Modified Davis grading.
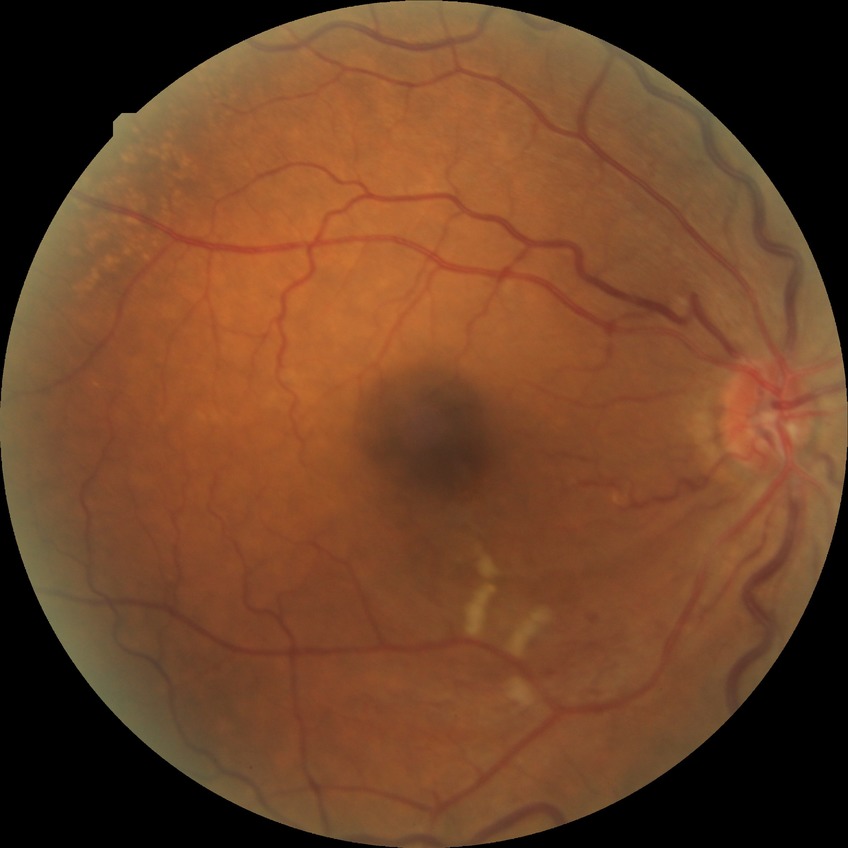
Diabetic retinopathy severity is no diabetic retinopathy.